Nonmydriatic fundus photograph. Posterior pole photograph: 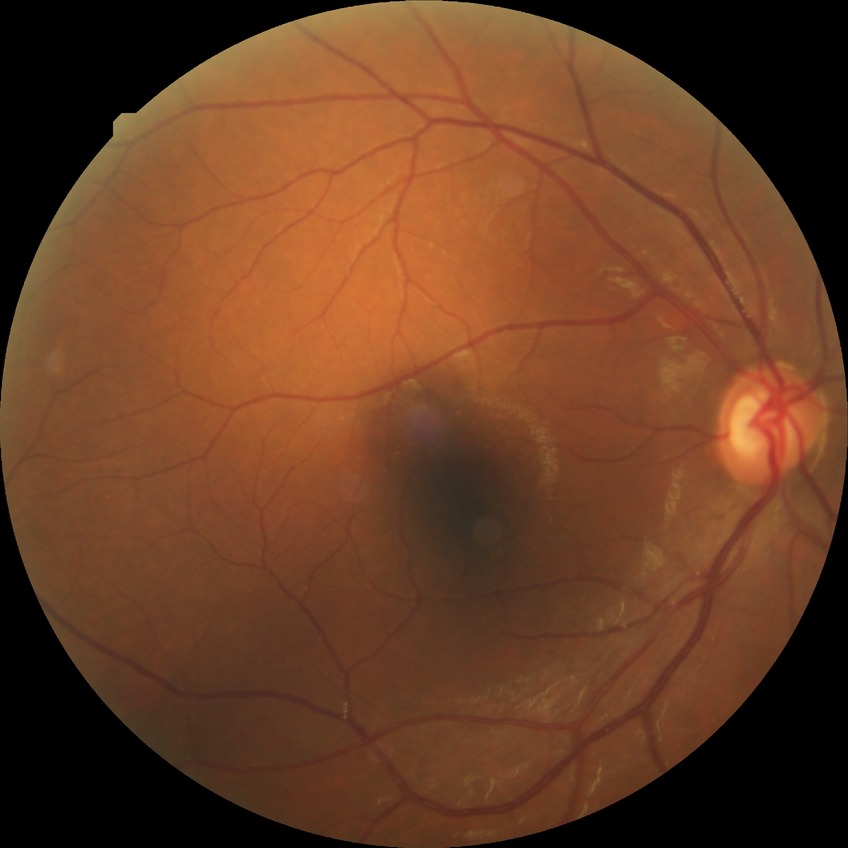 Diabetic retinopathy (DR) is NDR (no diabetic retinopathy).